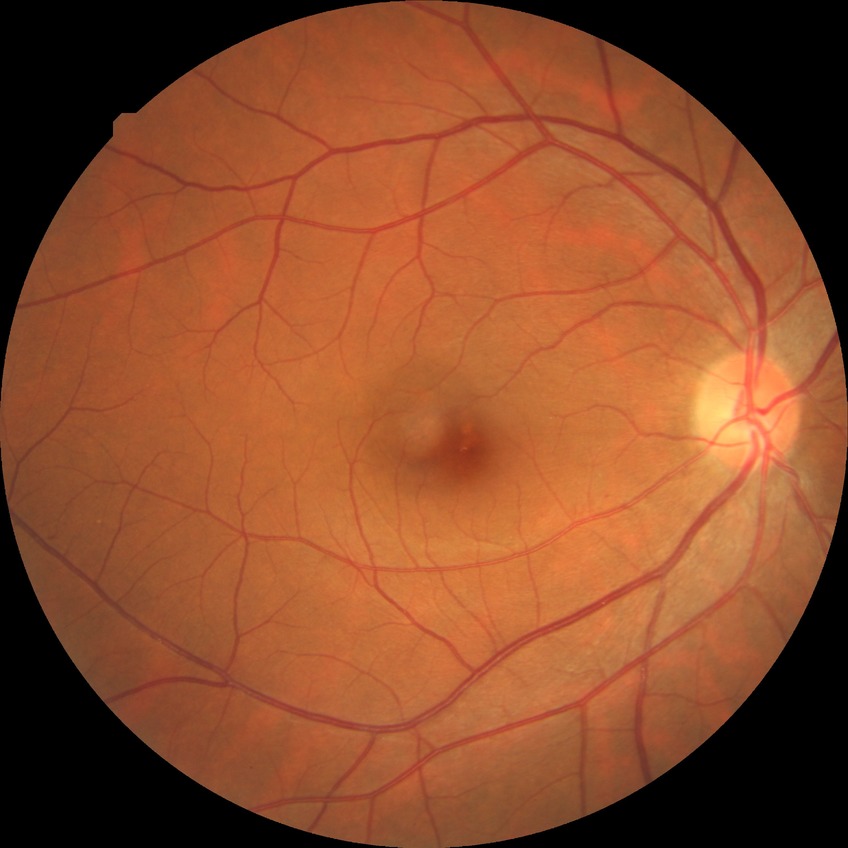 No signs of diabetic retinopathy. Davis DR grade: NDR.